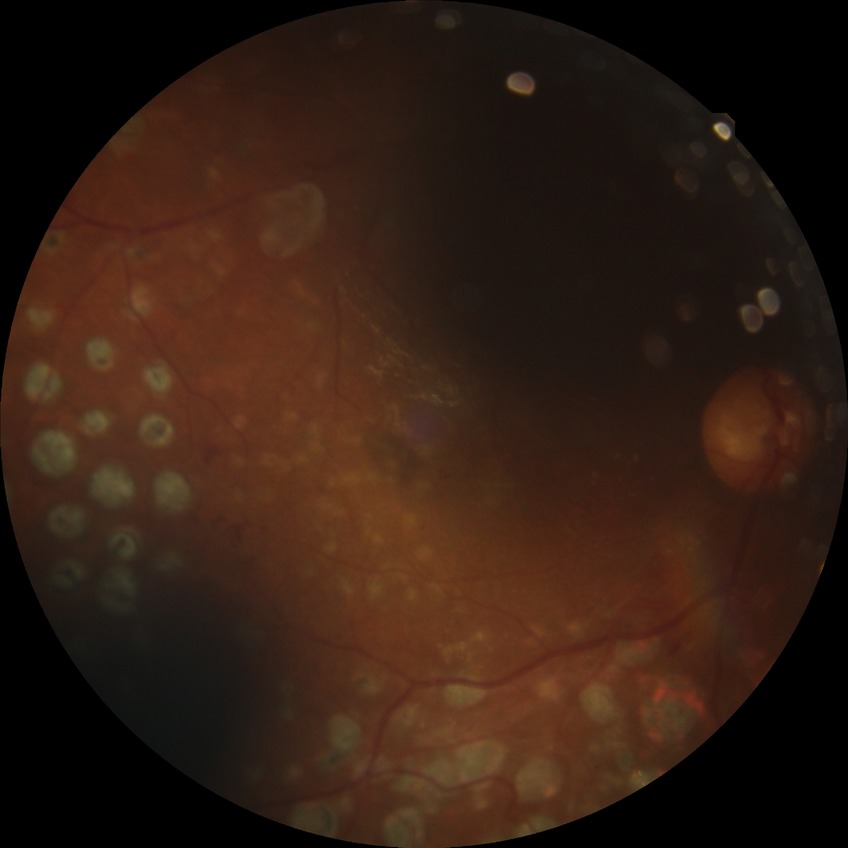
Annotations:
• diabetic retinopathy (DR) — proliferative diabetic retinopathy (PDR)